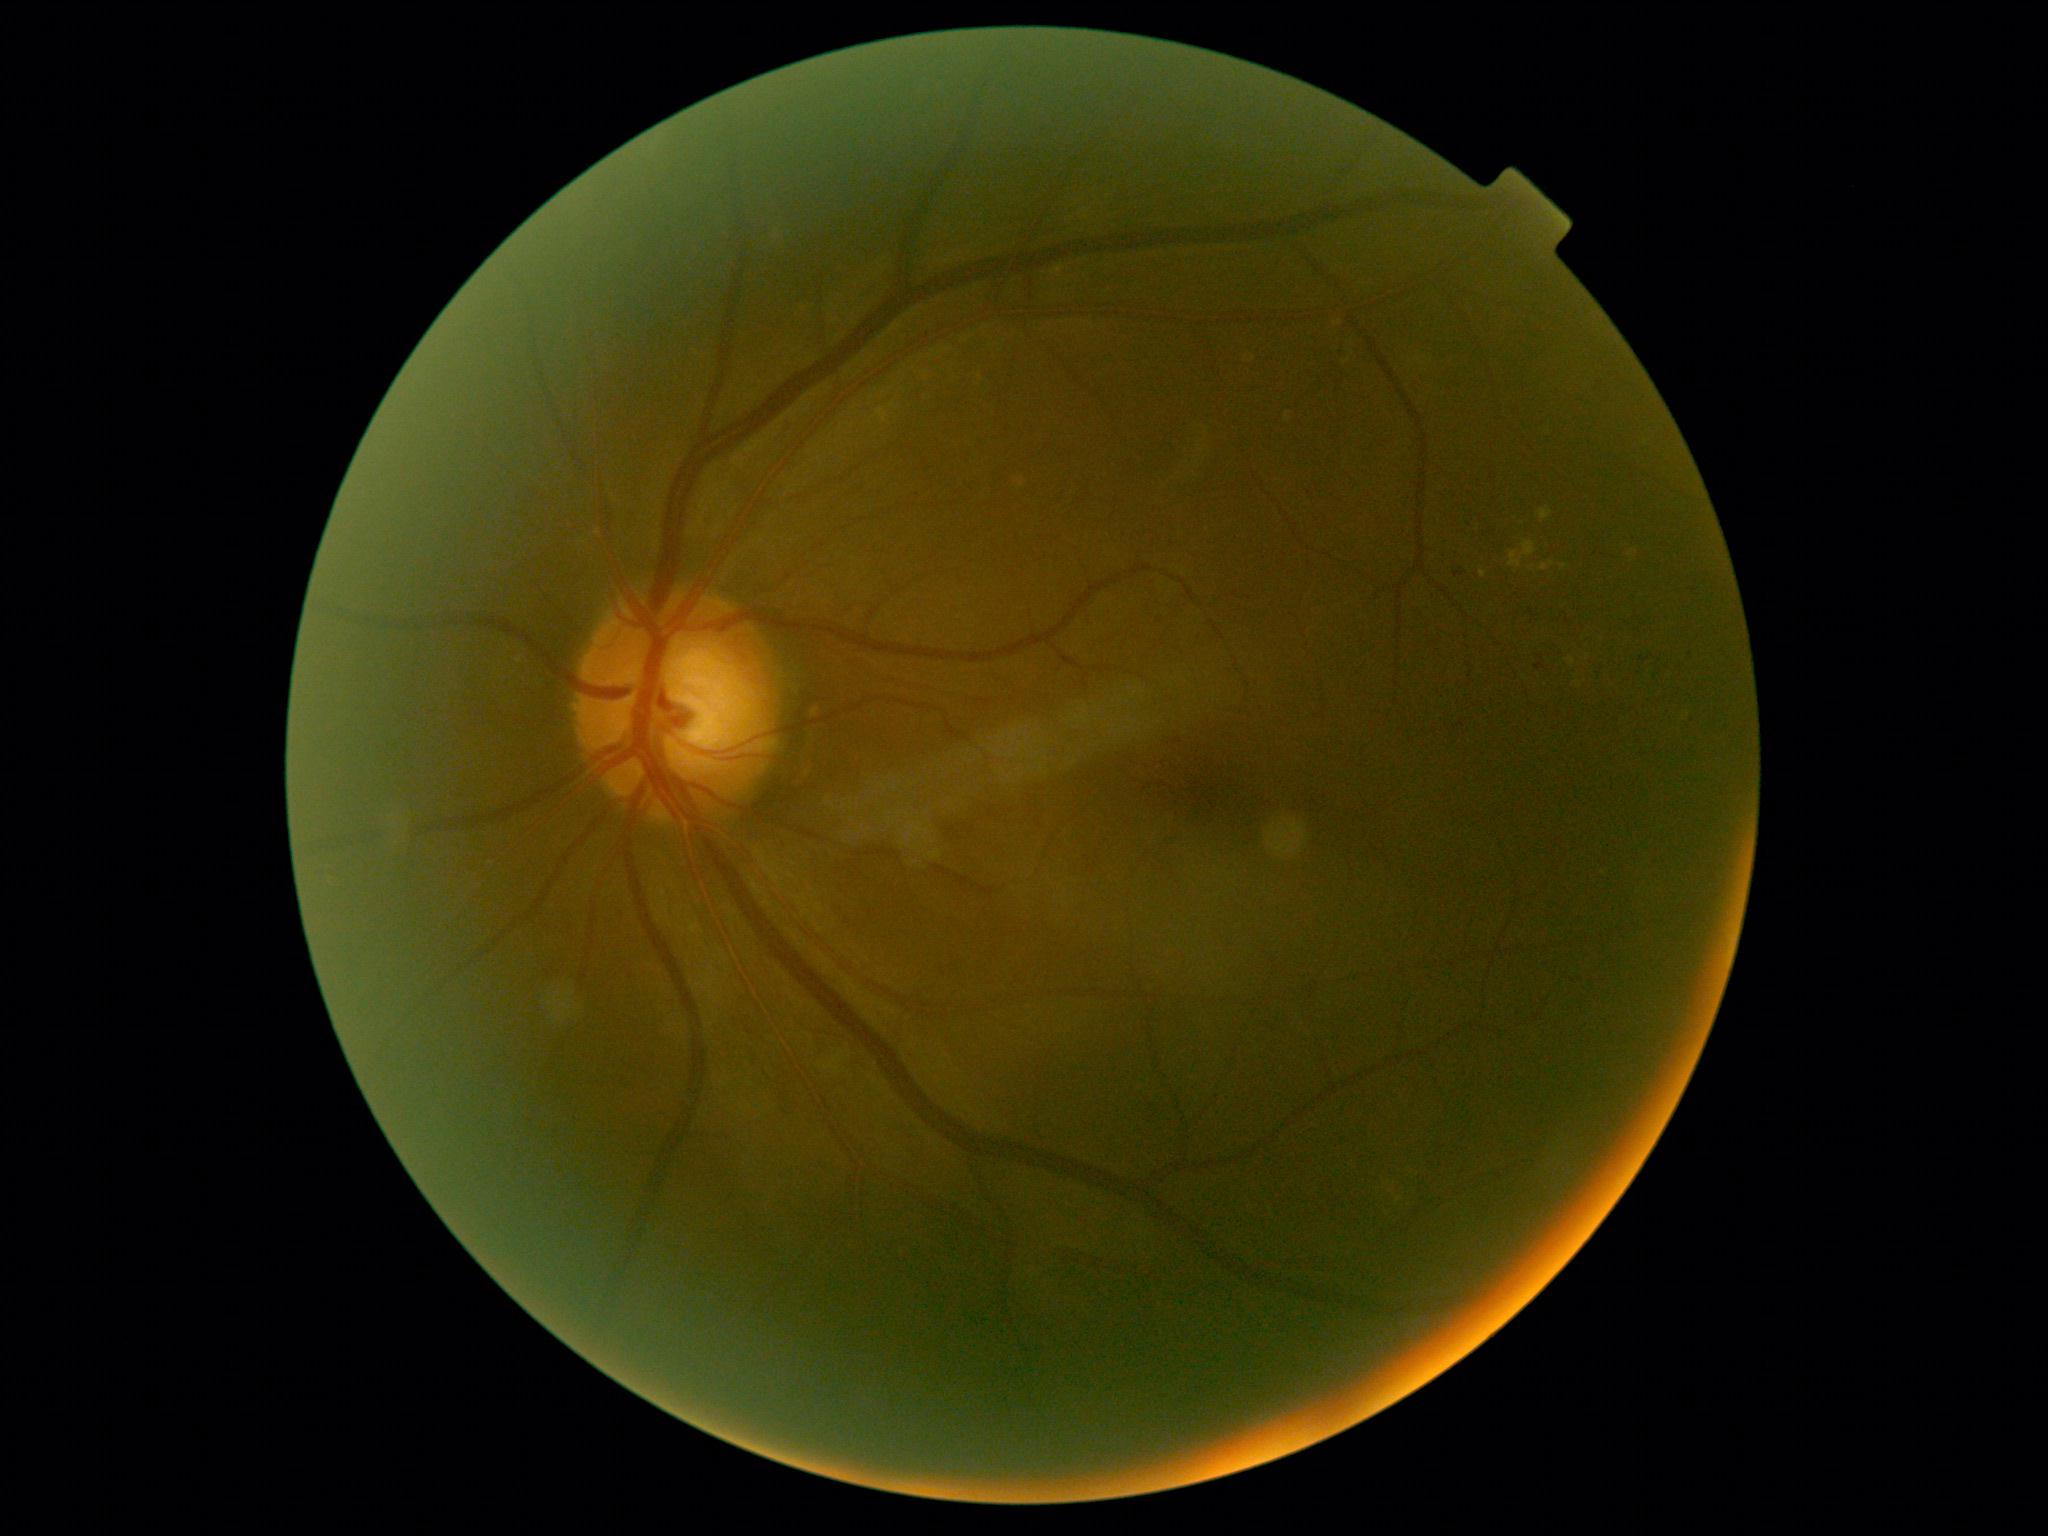

Annotations:
– diabetic retinopathy grade: moderate NPDR (2)